Color fundus photograph; 50-degree field of view.
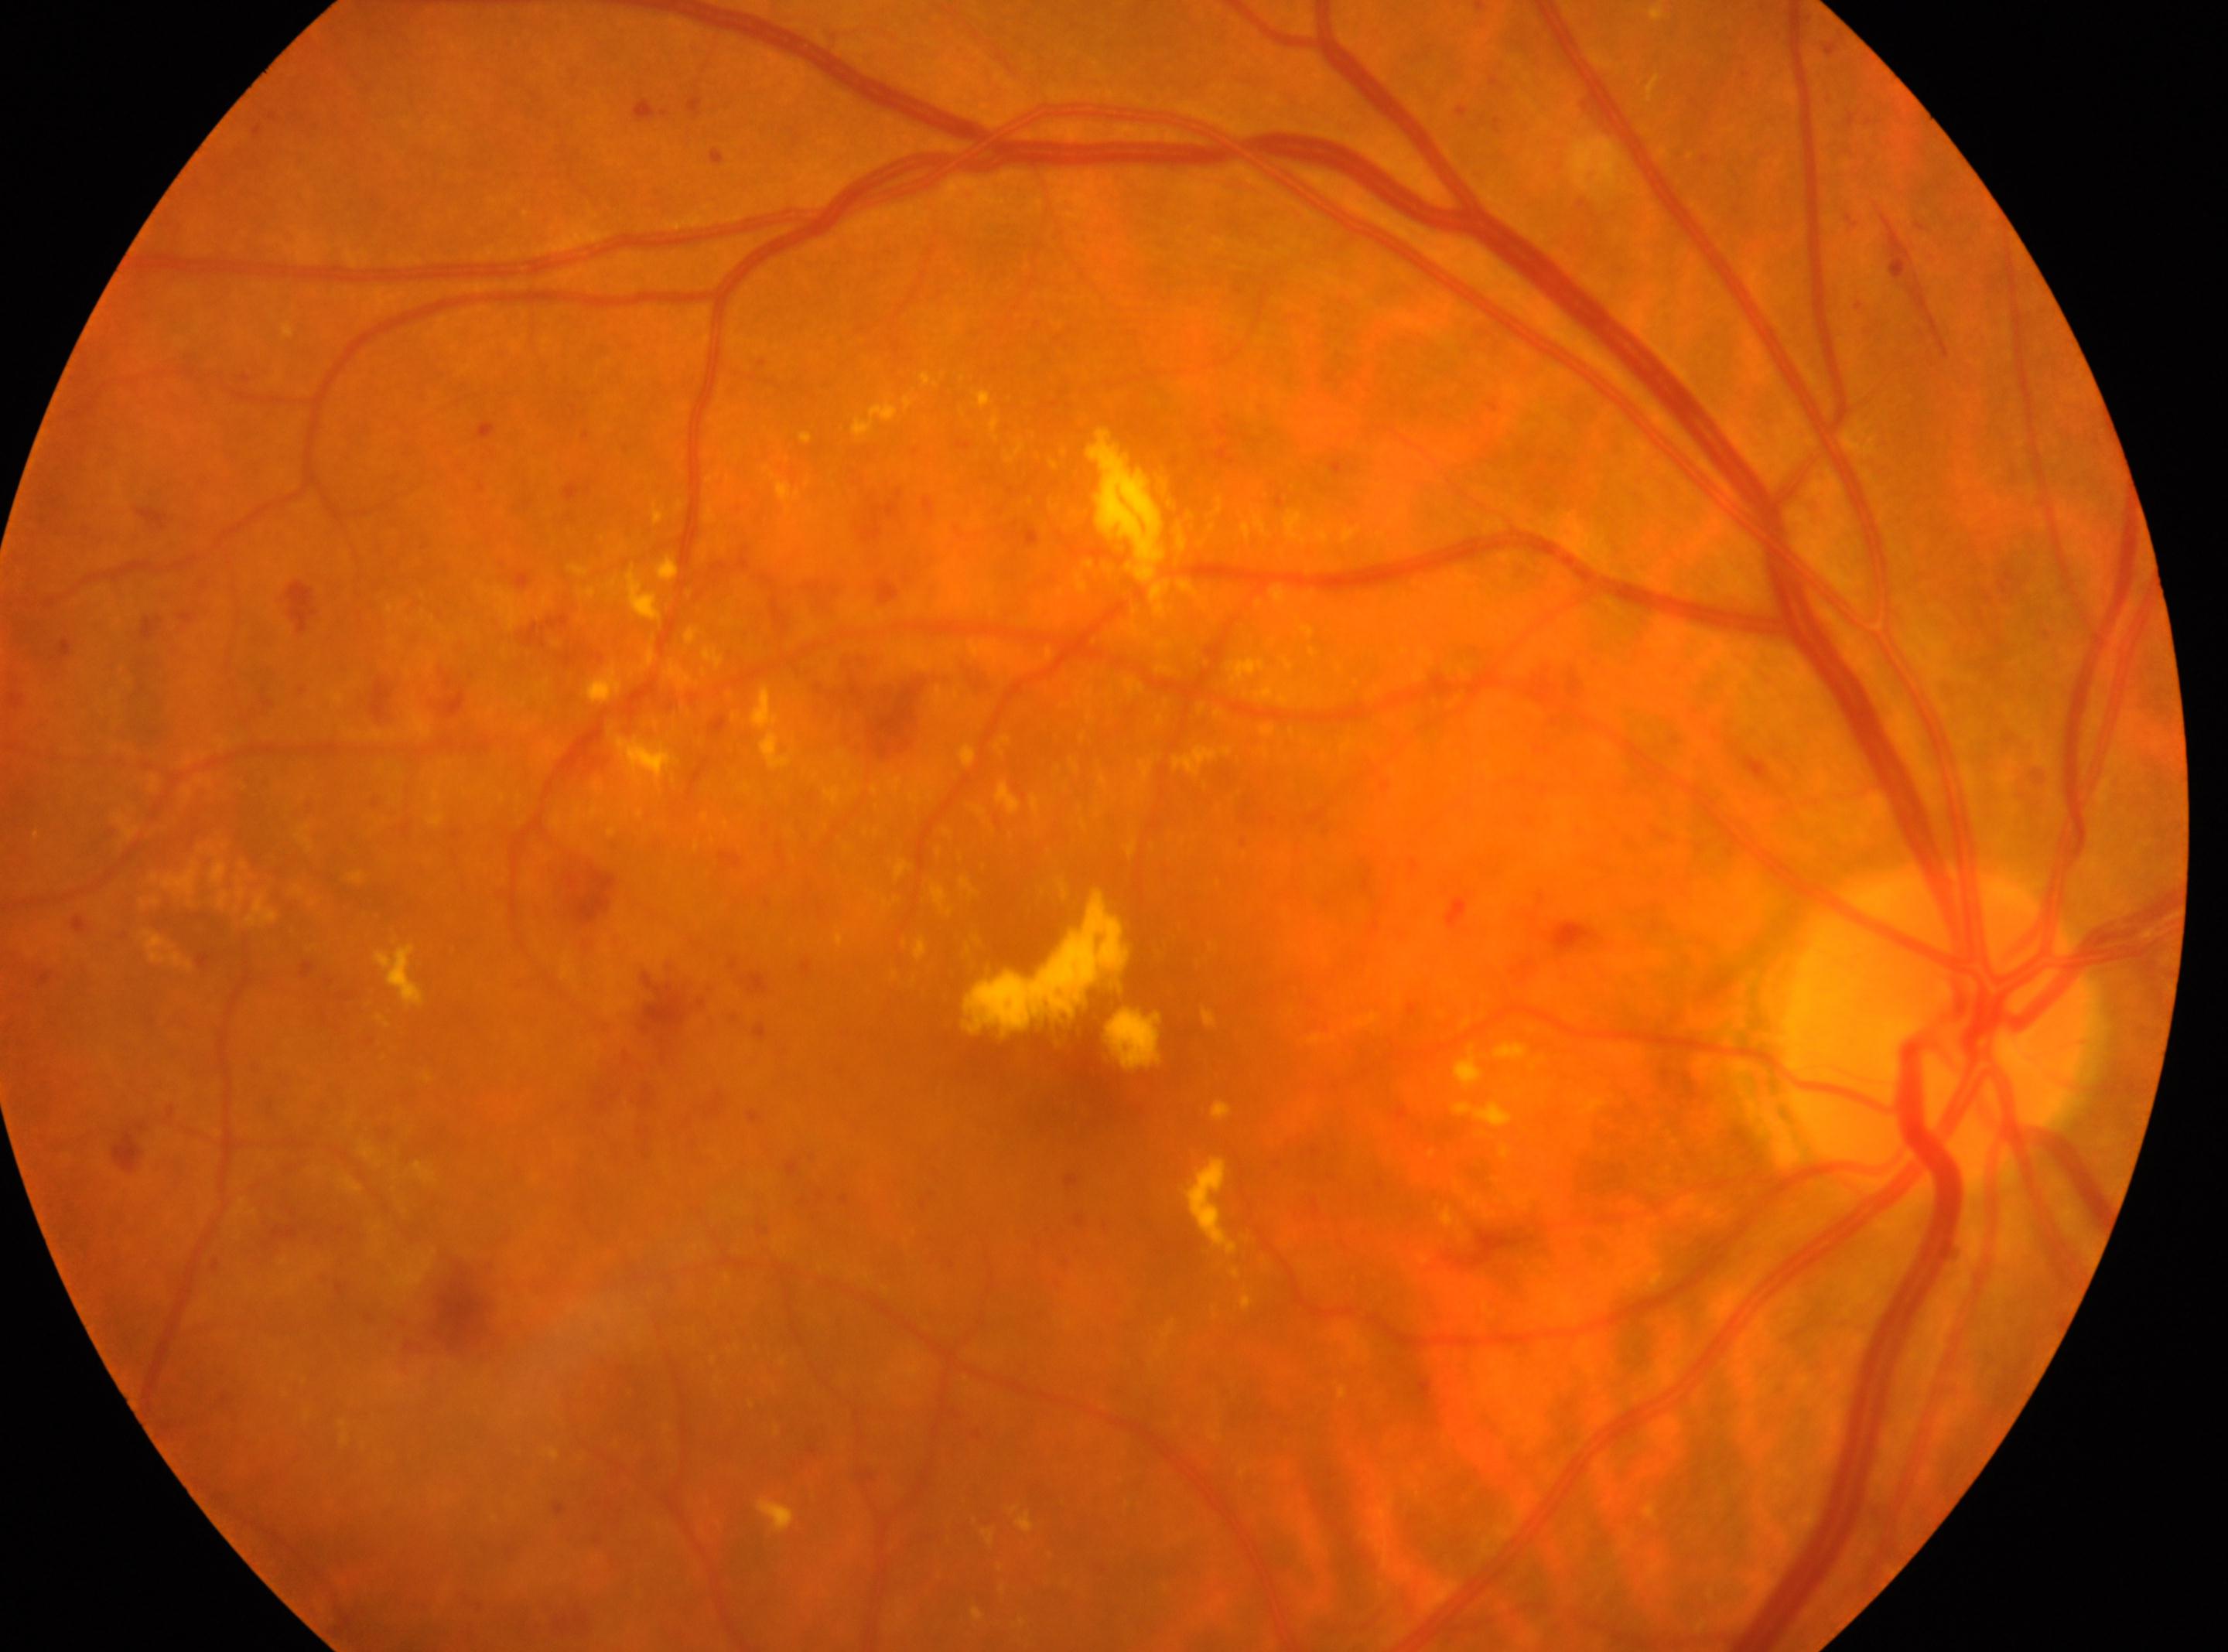

Macular center located at 1071, 1114.
The optic disk is at 1939, 1033.
This is the right eye.
DR is 2.